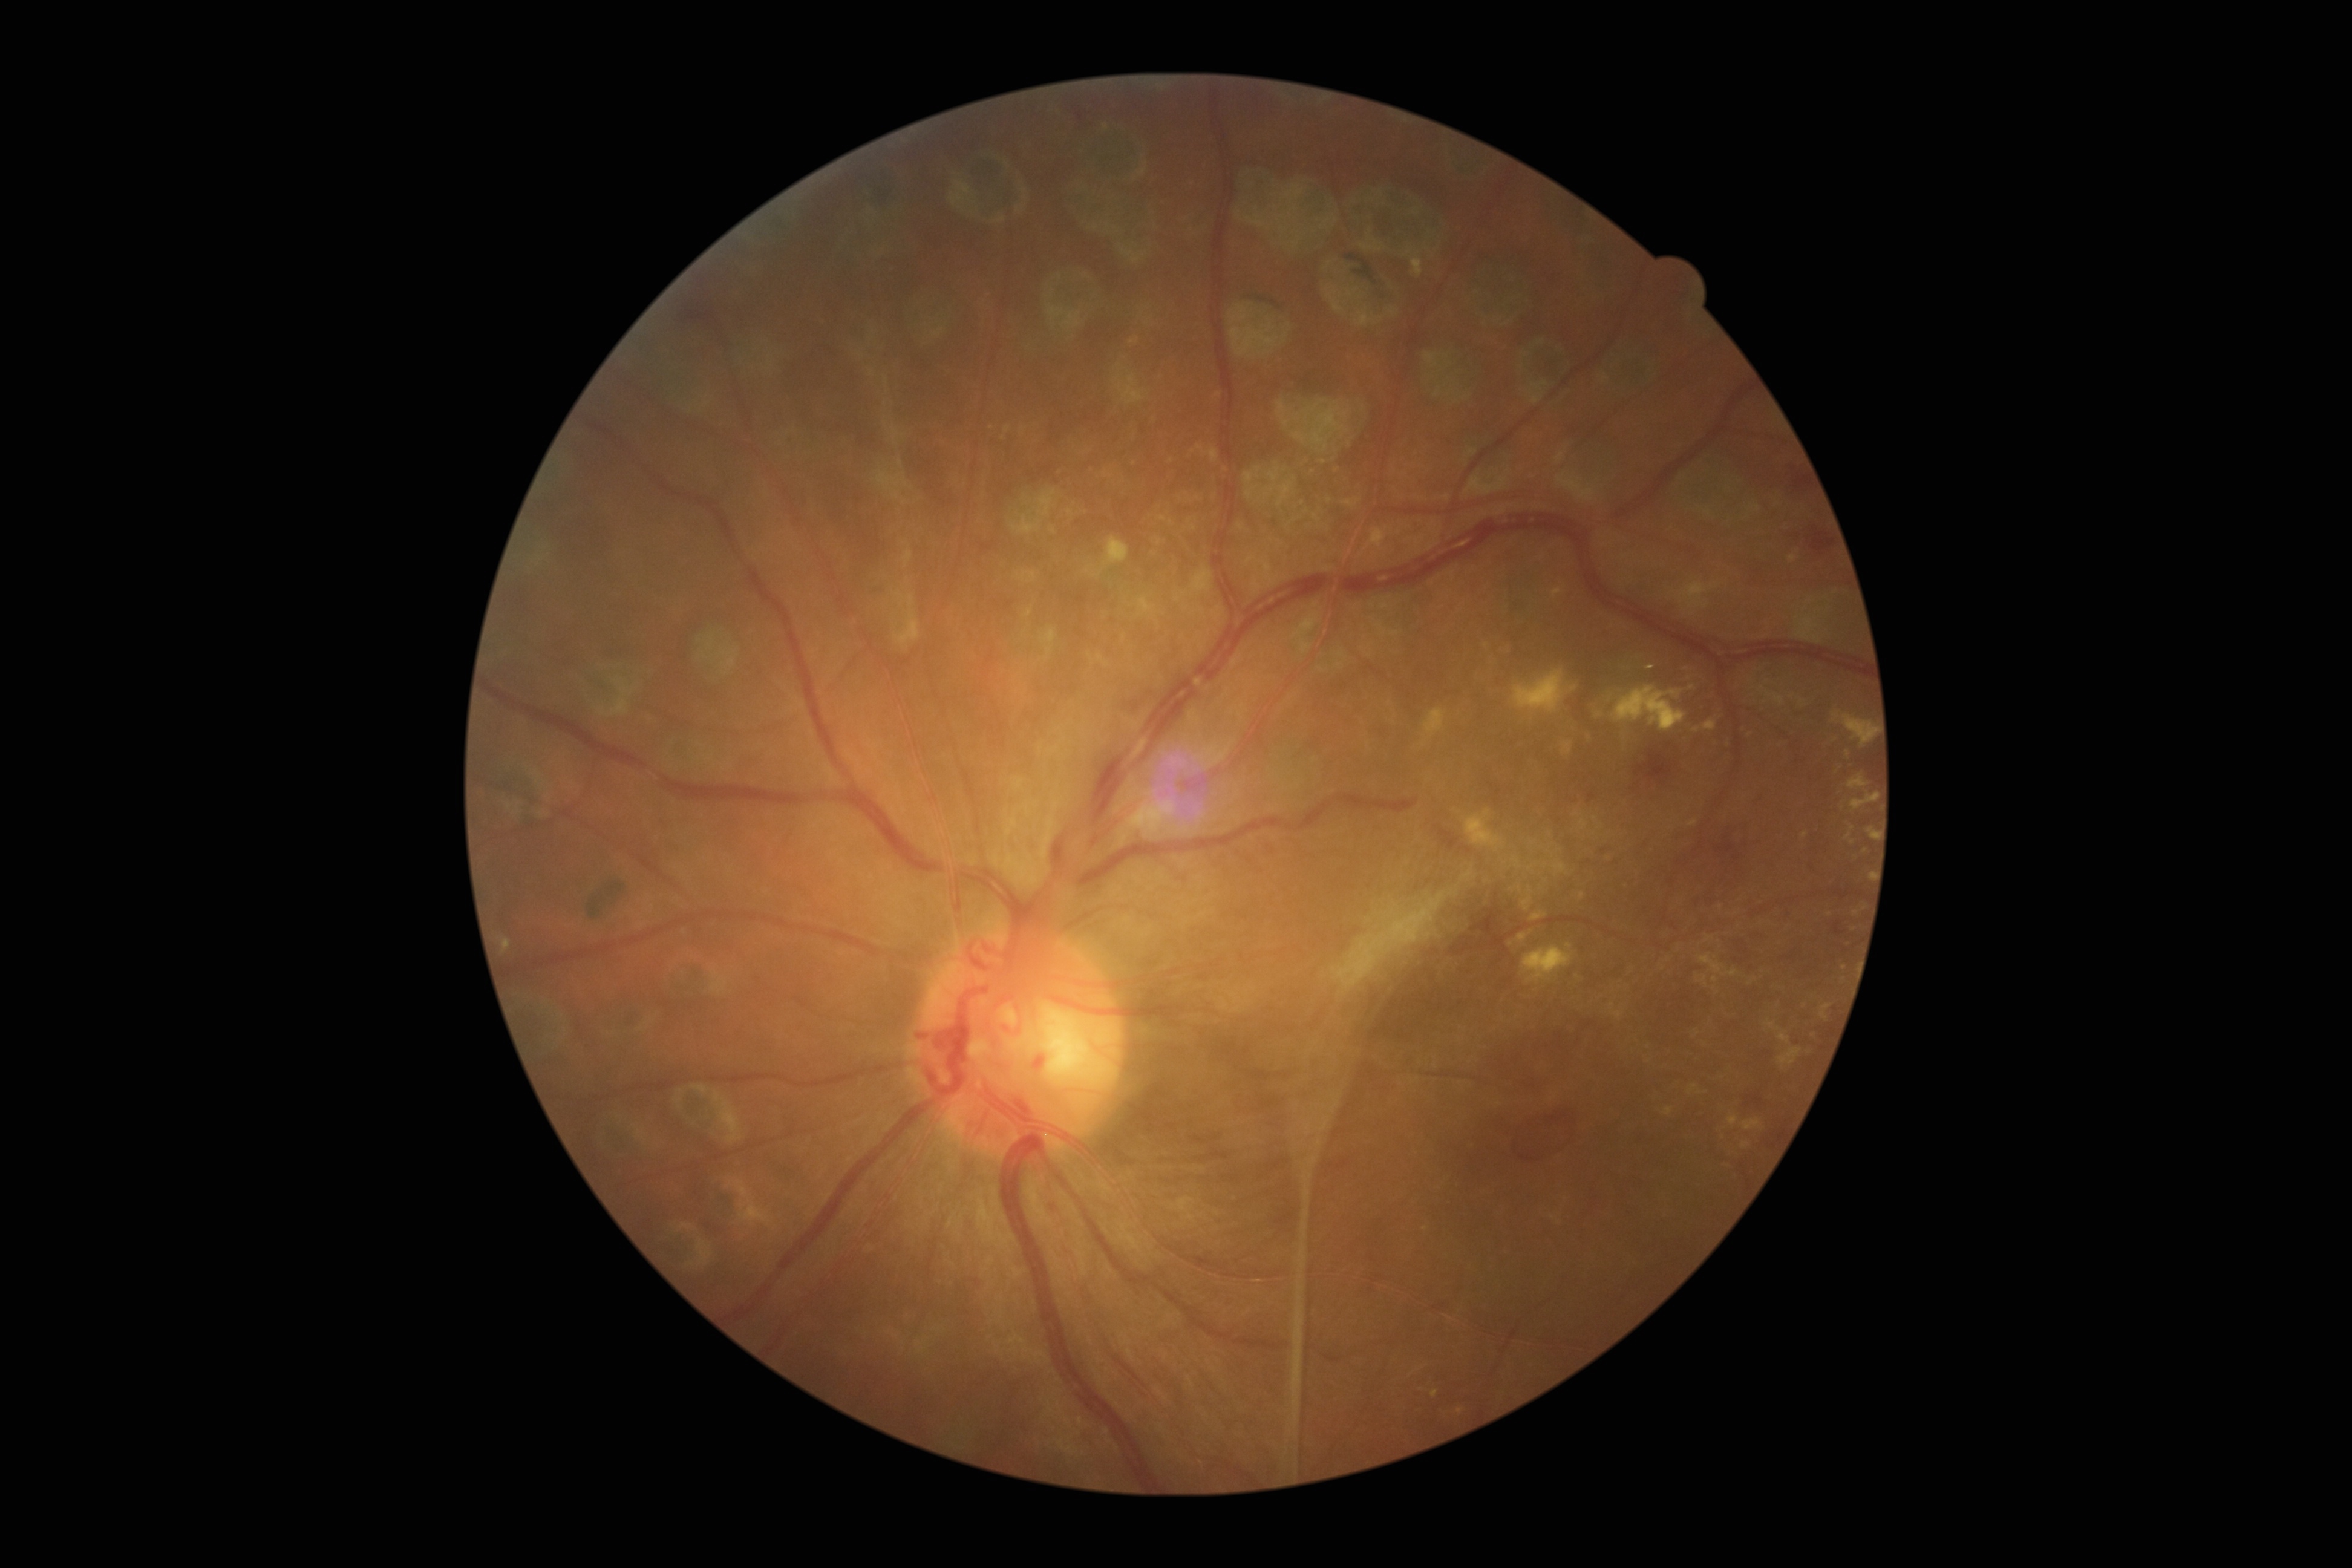
DR stage: PDR (grade 4). No SEs identified. HEs present at <region>1589, 794, 1595, 802</region>; <region>1835, 923, 1843, 935</region>; <region>1700, 822, 1740, 880</region>; <region>1811, 533, 1836, 555</region>; <region>1267, 1162, 1281, 1168</region>; <region>1636, 751, 1671, 779</region>; <region>1795, 475, 1812, 489</region>; <region>685, 312, 713, 322</region>; <region>1471, 912, 1507, 952</region>; <region>1338, 1162, 1347, 1168</region>; <region>1439, 828, 1459, 850</region>. EXs include <region>1832, 711, 1877, 748</region>; <region>1423, 708, 1448, 739</region>; <region>1869, 827, 1878, 840</region>; <region>1847, 774, 1870, 789</region>; <region>1466, 810, 1504, 851</region>; <region>1523, 946, 1573, 983</region>; <region>1844, 833, 1852, 840</region>; <region>1870, 872, 1873, 880</region>; <region>1851, 793, 1880, 810</region>; <region>1612, 685, 1687, 731</region>; <region>1513, 670, 1569, 713</region>. Small EXs near <pt>1853,842</pt>; <pt>1866,850</pt>; <pt>1848,754</pt>. No MAs identified.